45° FOV:
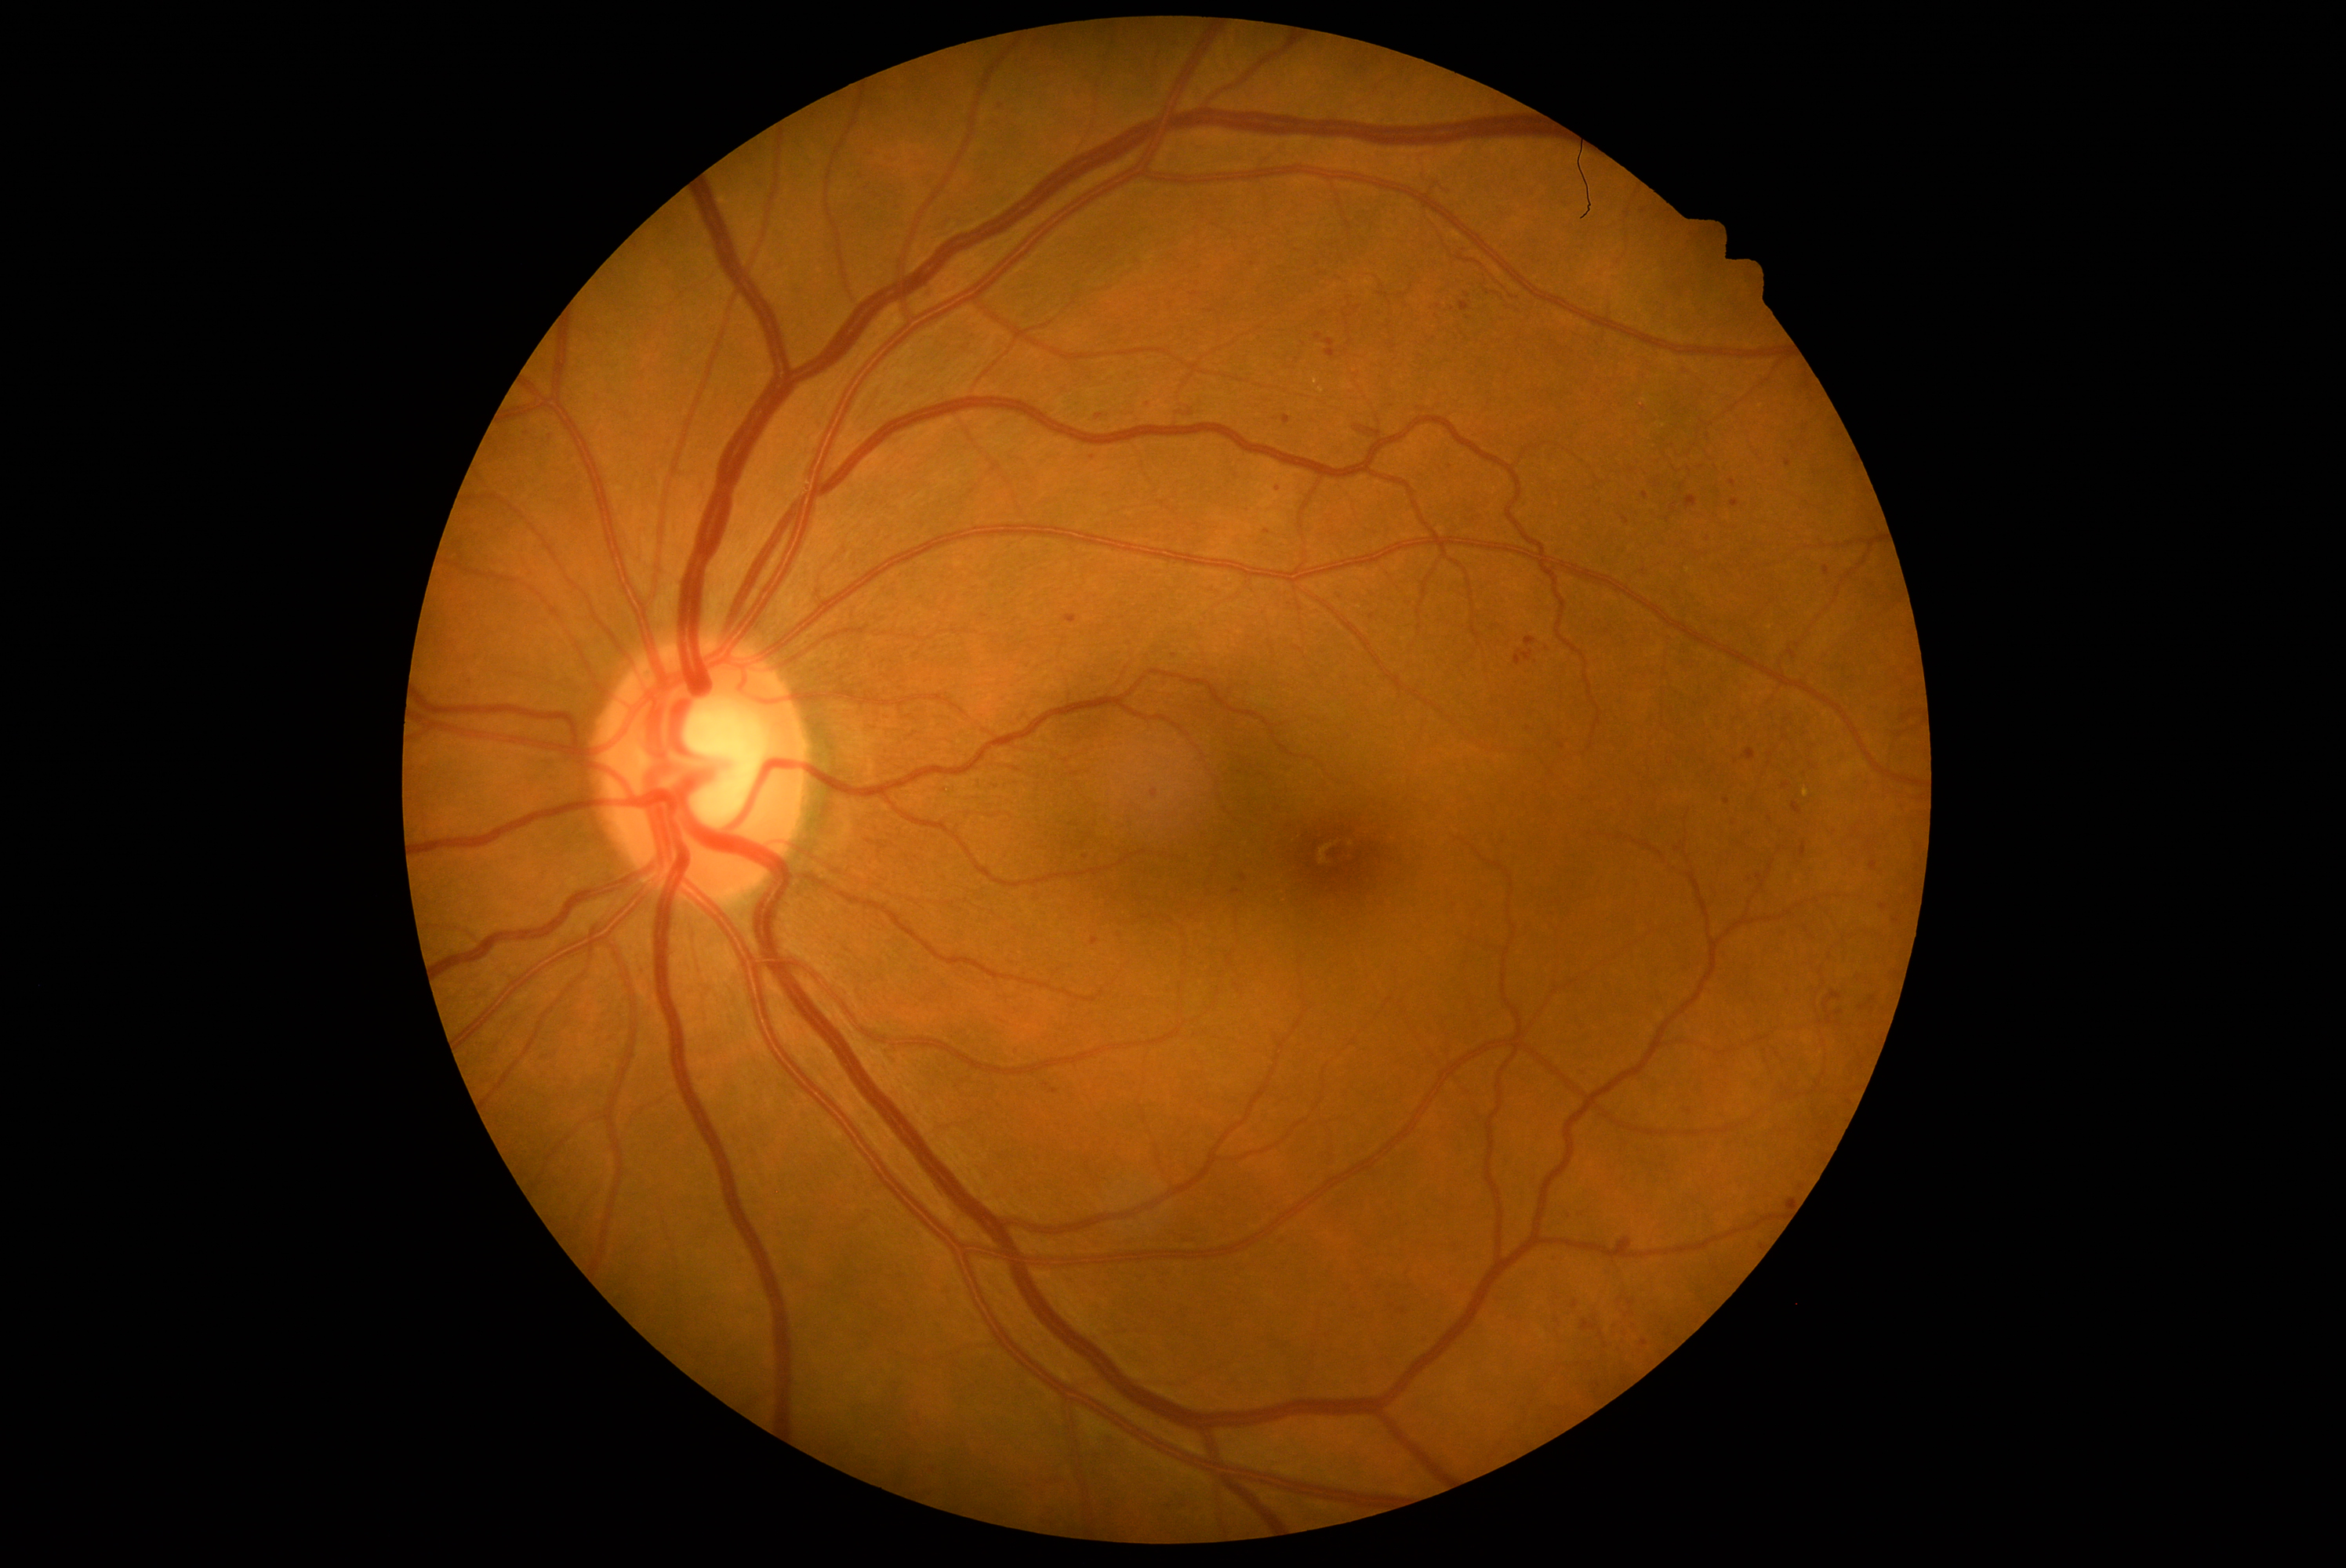
DR severity: grade 2
A subset of detected lesions:
MAs (partial) = <region>1139, 396, 1155, 412</region>; <region>1774, 927, 1787, 940</region>; <region>1166, 1229, 1200, 1244</region>; <region>1829, 829, 1839, 837</region>; <region>663, 434, 677, 448</region>; <region>1561, 1211, 1572, 1221</region>; <region>1050, 1089, 1059, 1095</region>; <region>1342, 1282, 1353, 1294</region>; <region>1136, 1272, 1147, 1283</region>; <region>1525, 637, 1538, 647</region>; <region>863, 150, 874, 158</region>
Small MAs approximately at [1174, 656]; [1873, 999]; [1267, 531]; [1786, 738]; [1736, 762]; [1597, 1386]; [1646, 495]; [1528, 729]